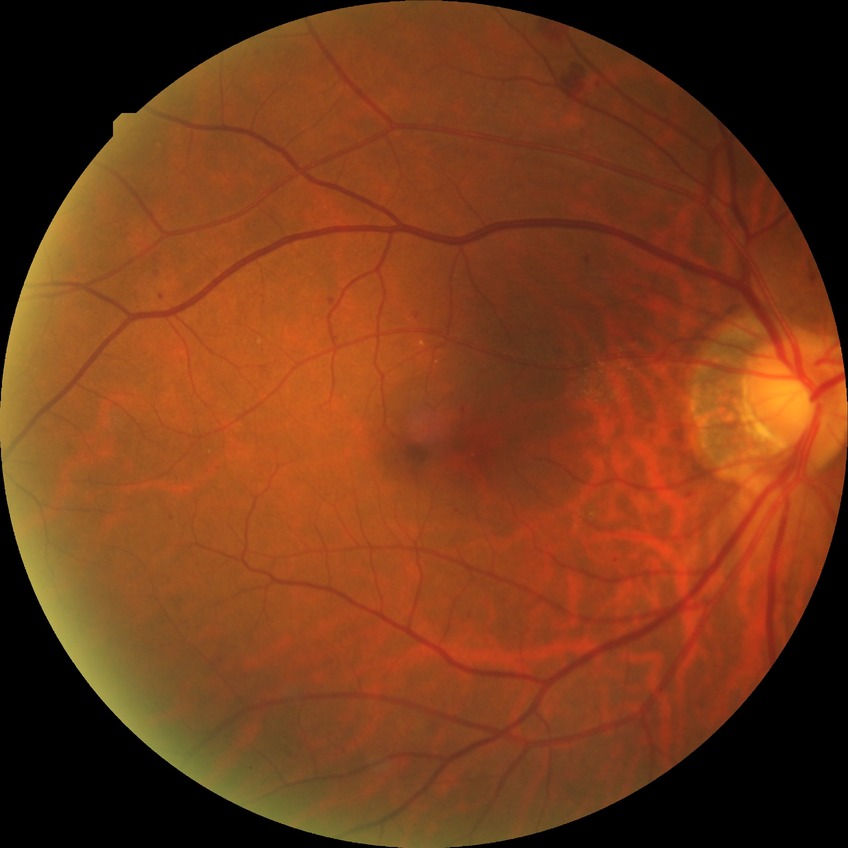 diabetic retinopathy (DR): simple diabetic retinopathy (SDR).